45° FOV — 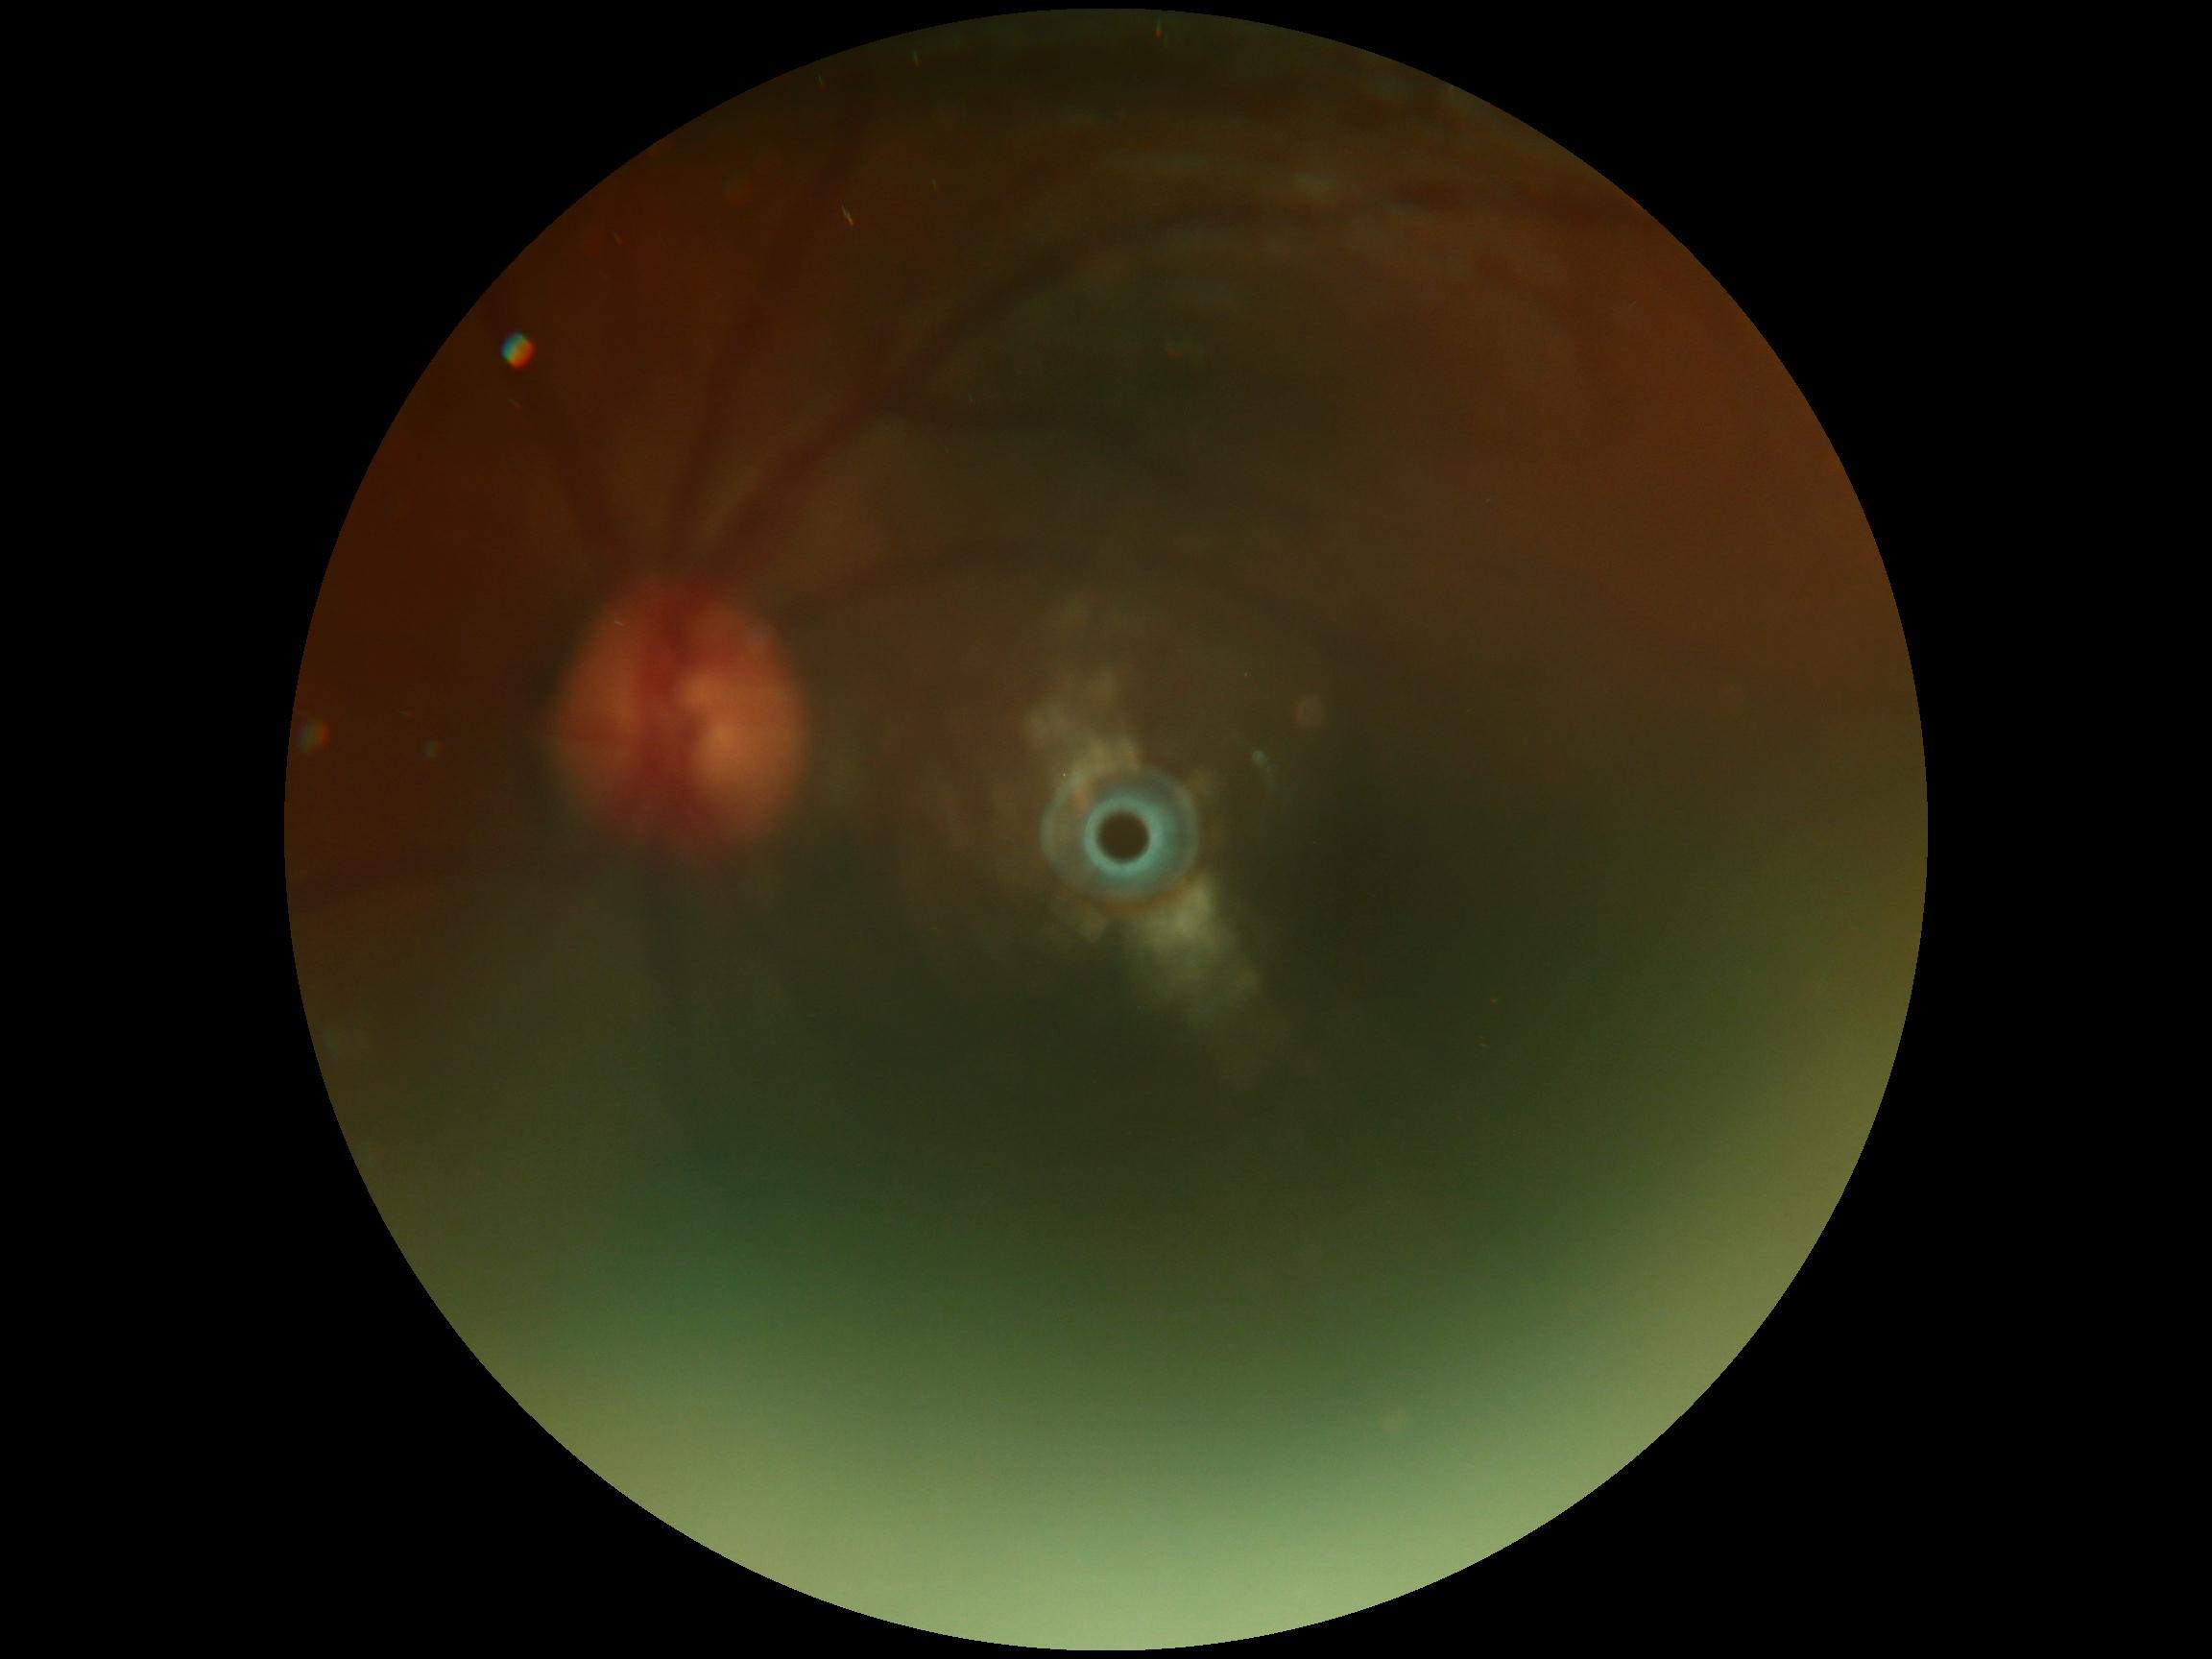
{"quality": "too poor for DR grading", "dr_grade": "ungradable due to poor image quality"}